Color fundus photograph — 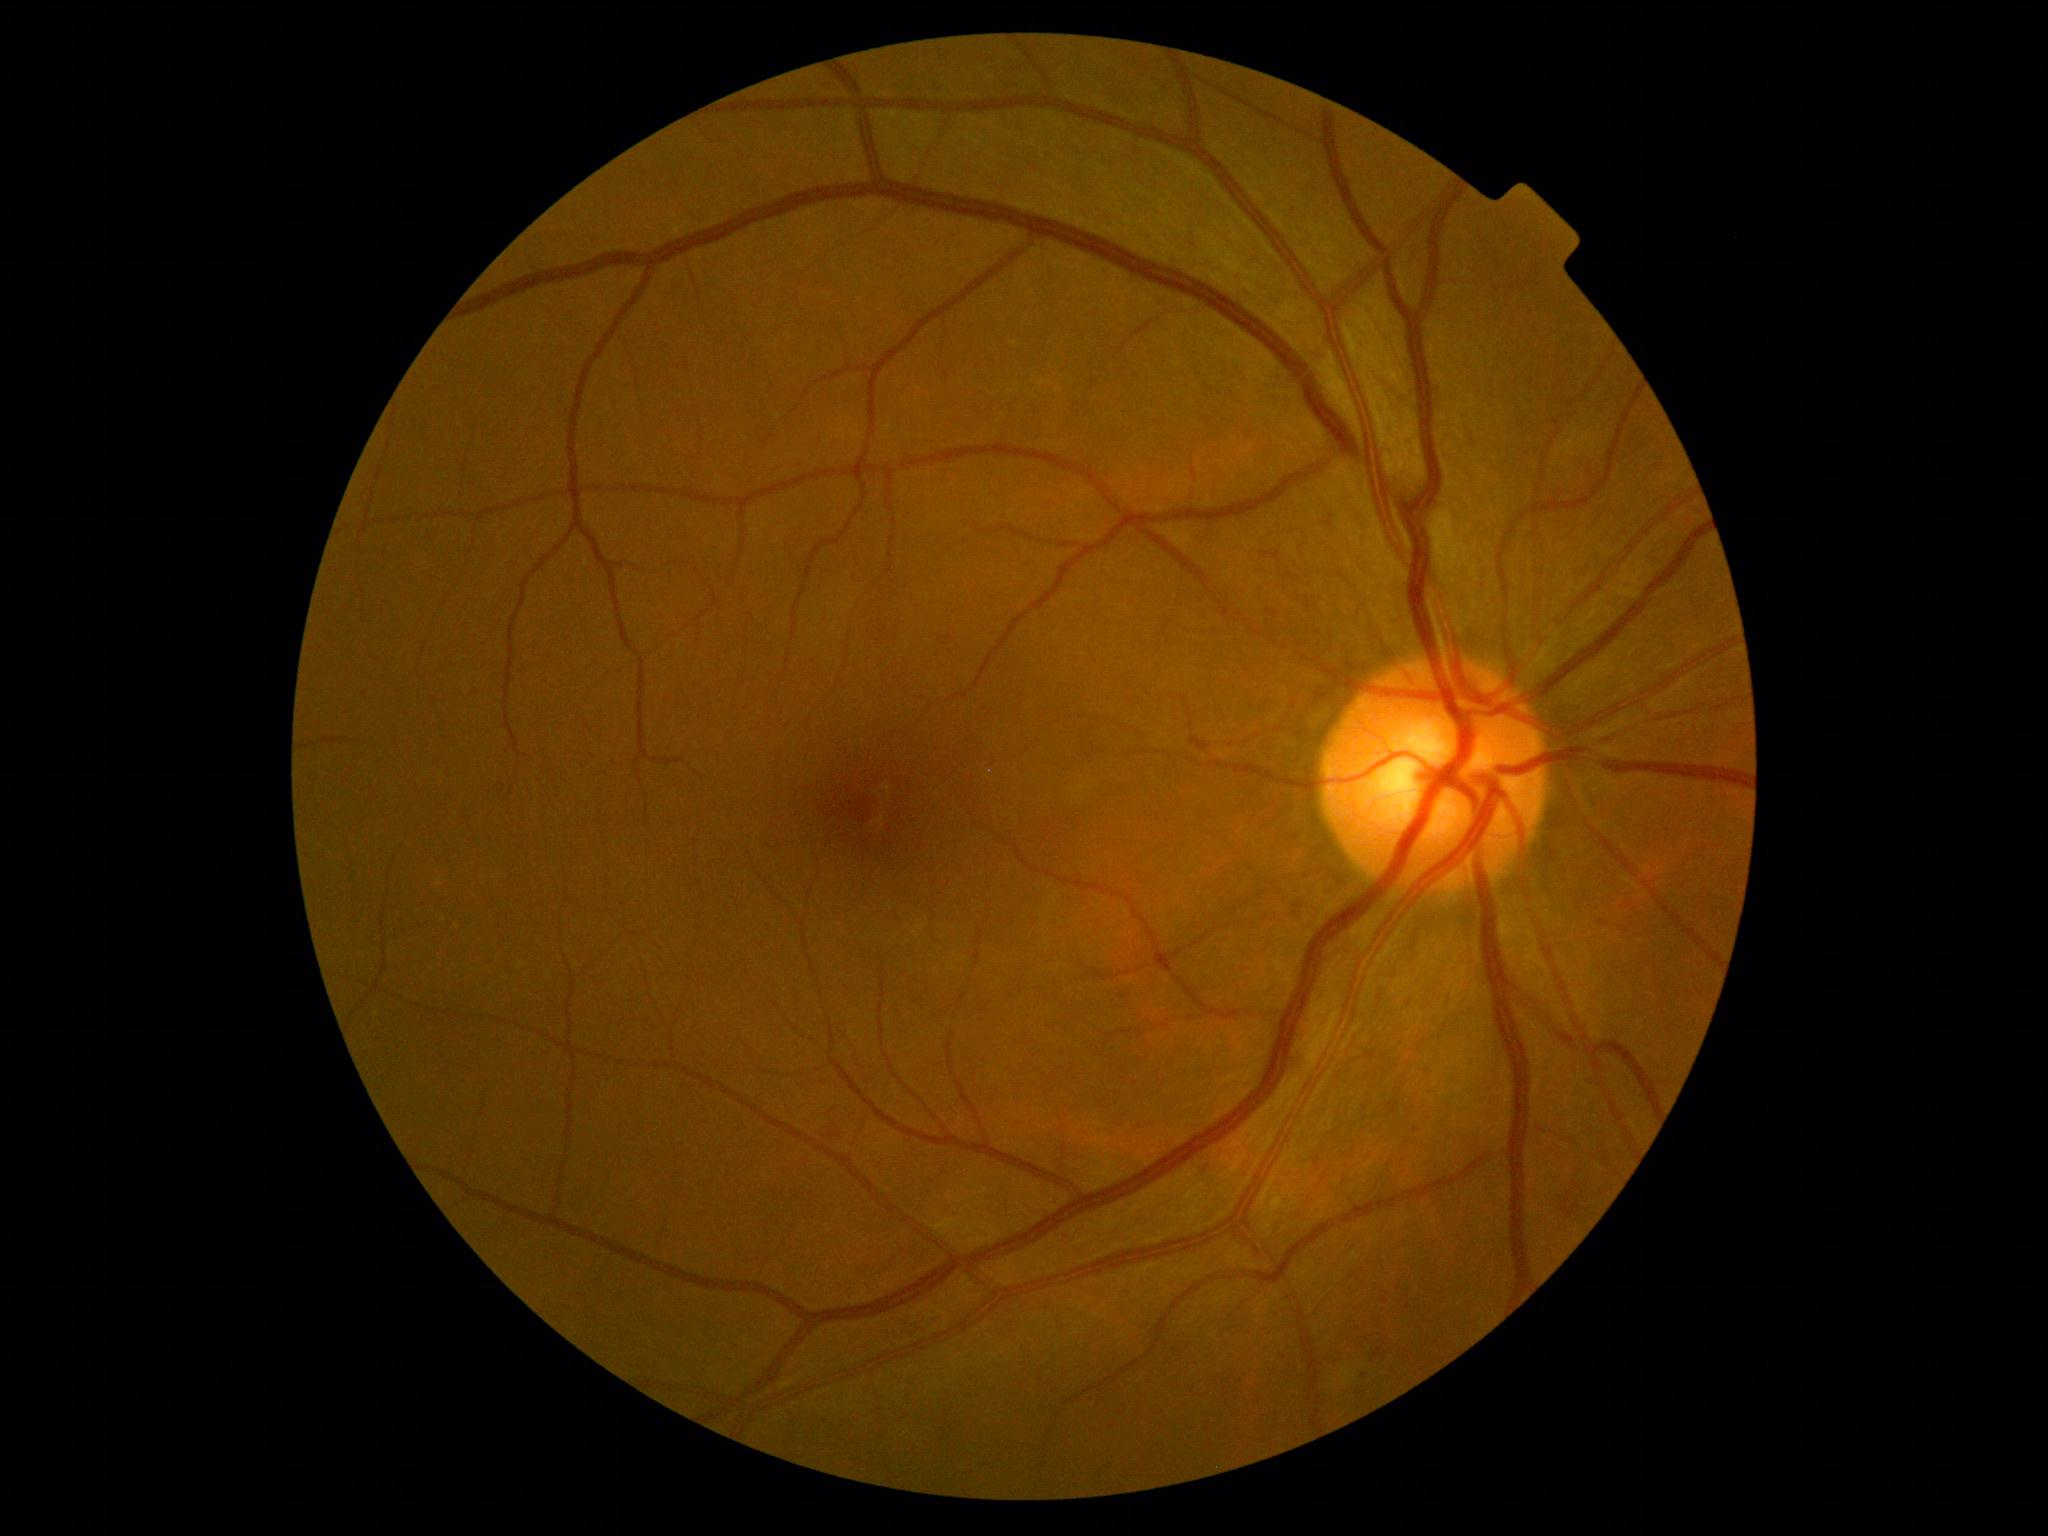
{"dr_grade": "grade 2 (moderate NPDR)"}